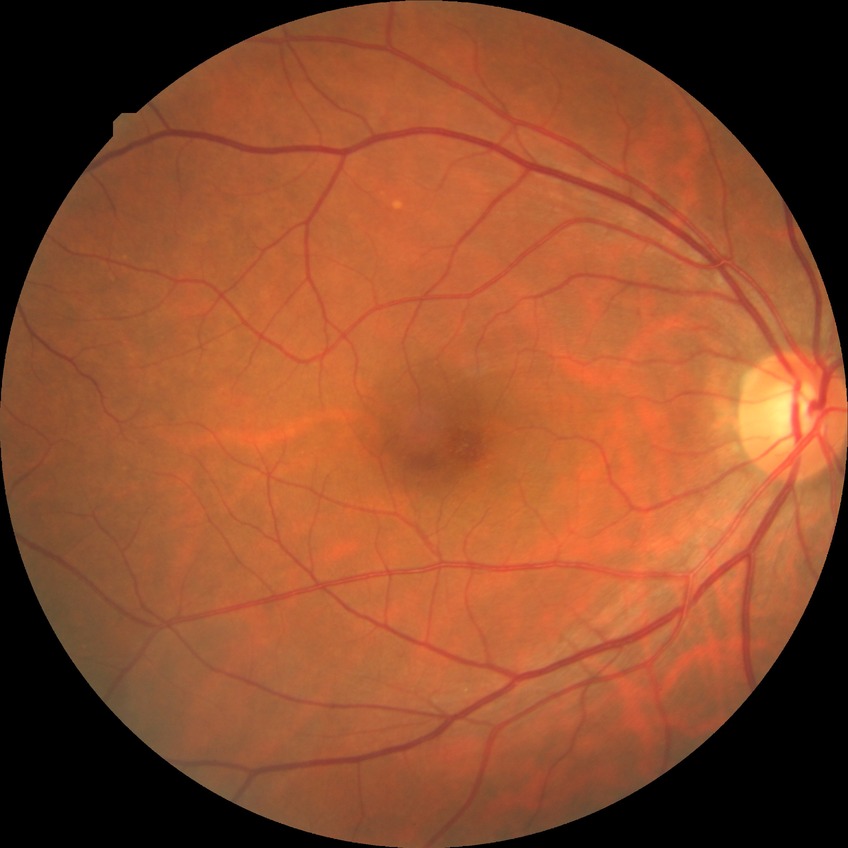 Diabetic retinopathy stage is no diabetic retinopathy.